2352x1568px: 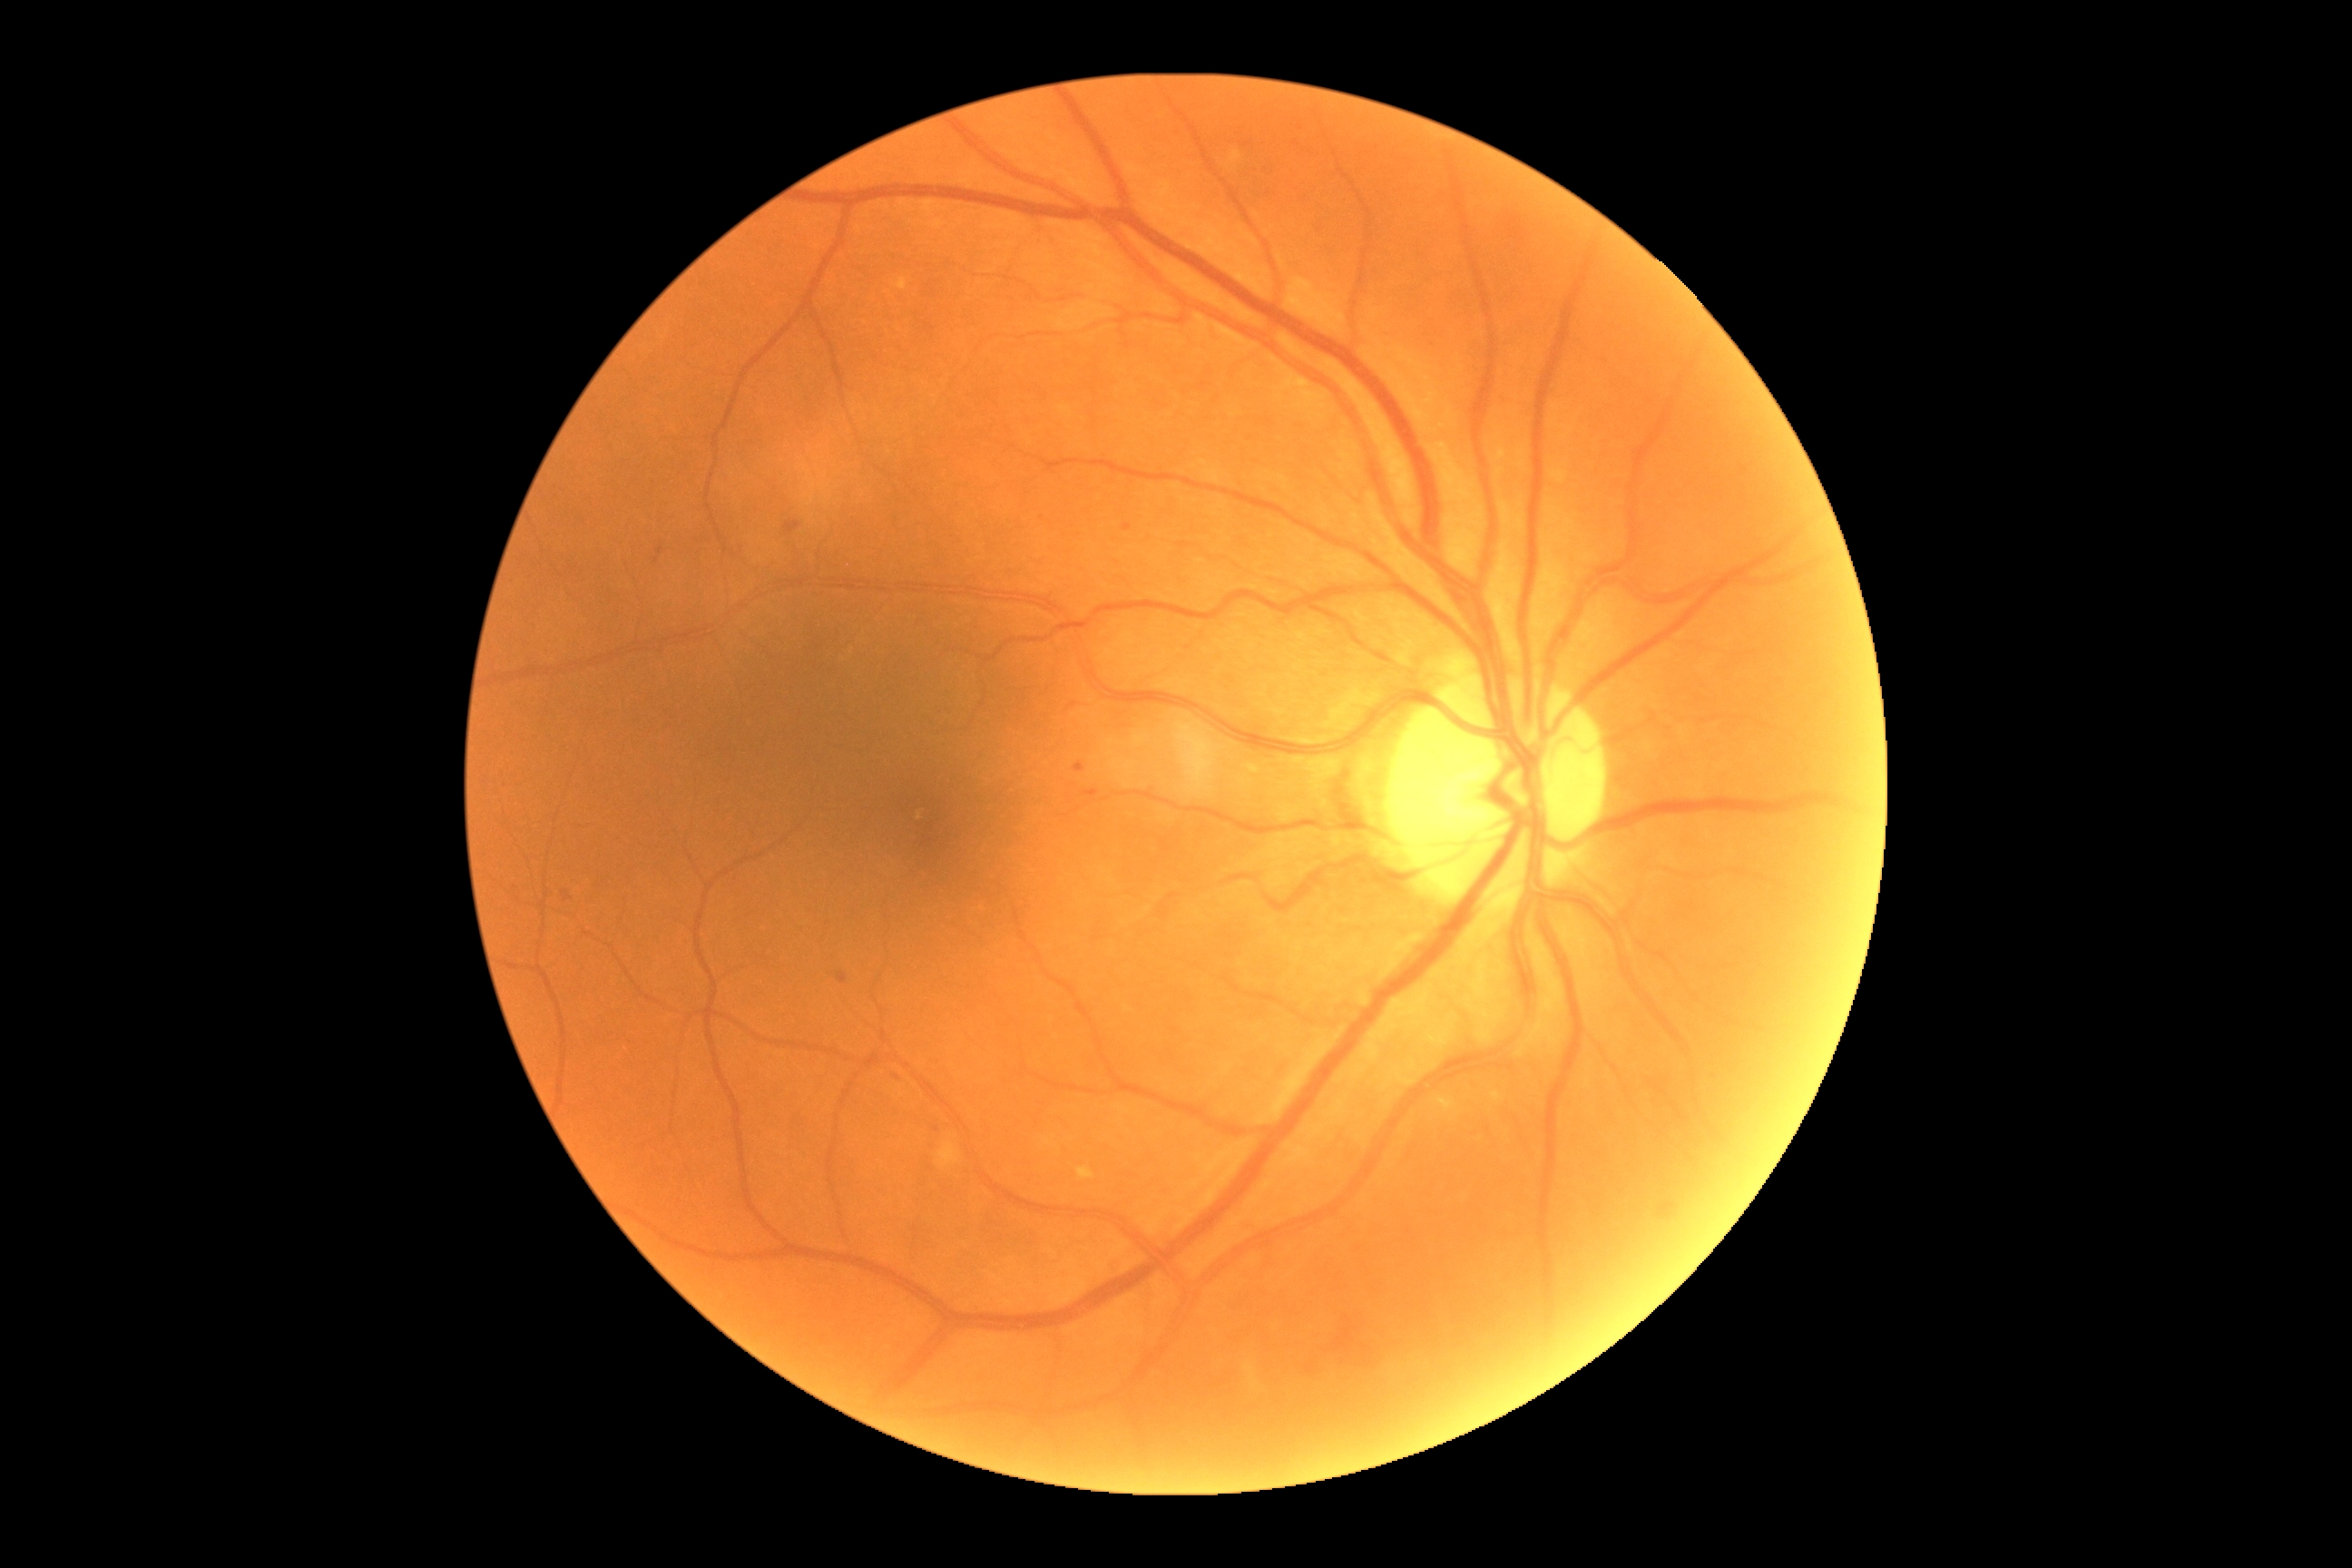 DR = moderate non-proliferative diabetic retinopathy (grade 2) | DR class = non-proliferative diabetic retinopathy.